2352 by 1568 pixels, 45-degree field of view, fundus photo: 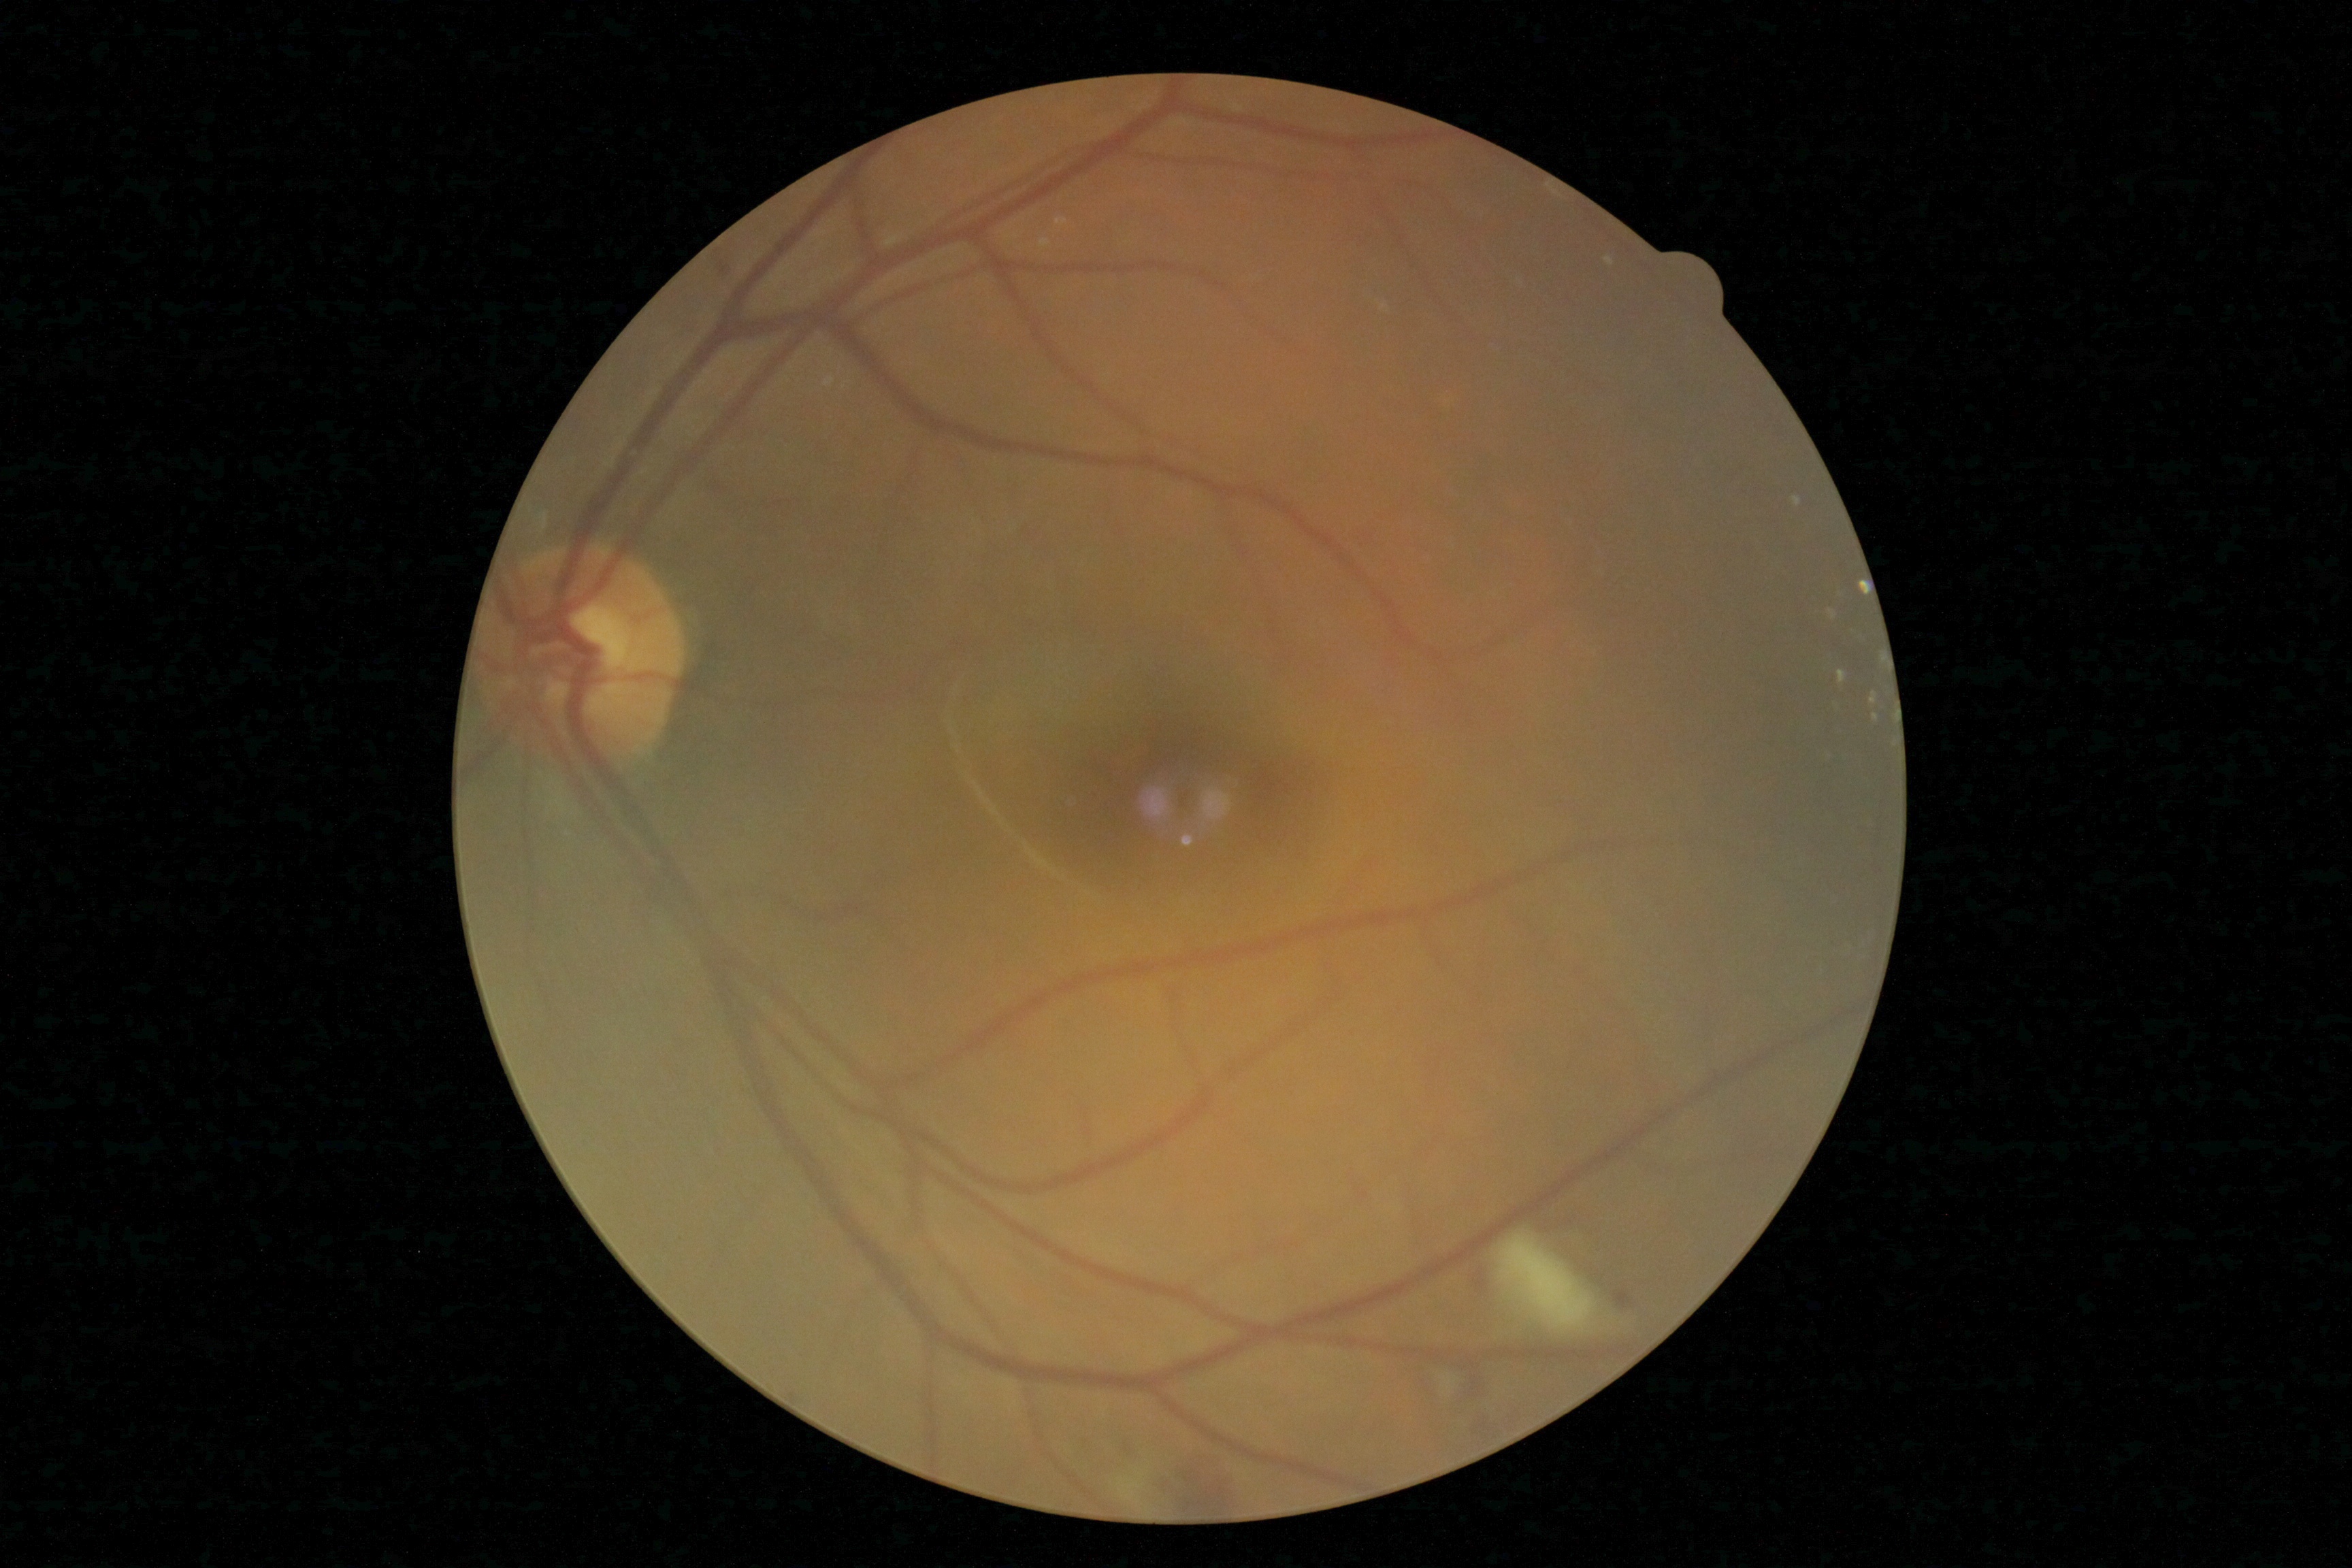
The retinopathy is classified as non-proliferative diabetic retinopathy.
Diabetic retinopathy (DR) is grade 2.